CFP.
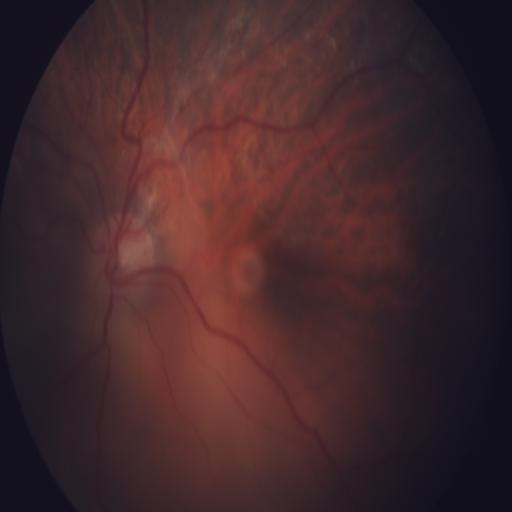

Demonstrates tessellation.